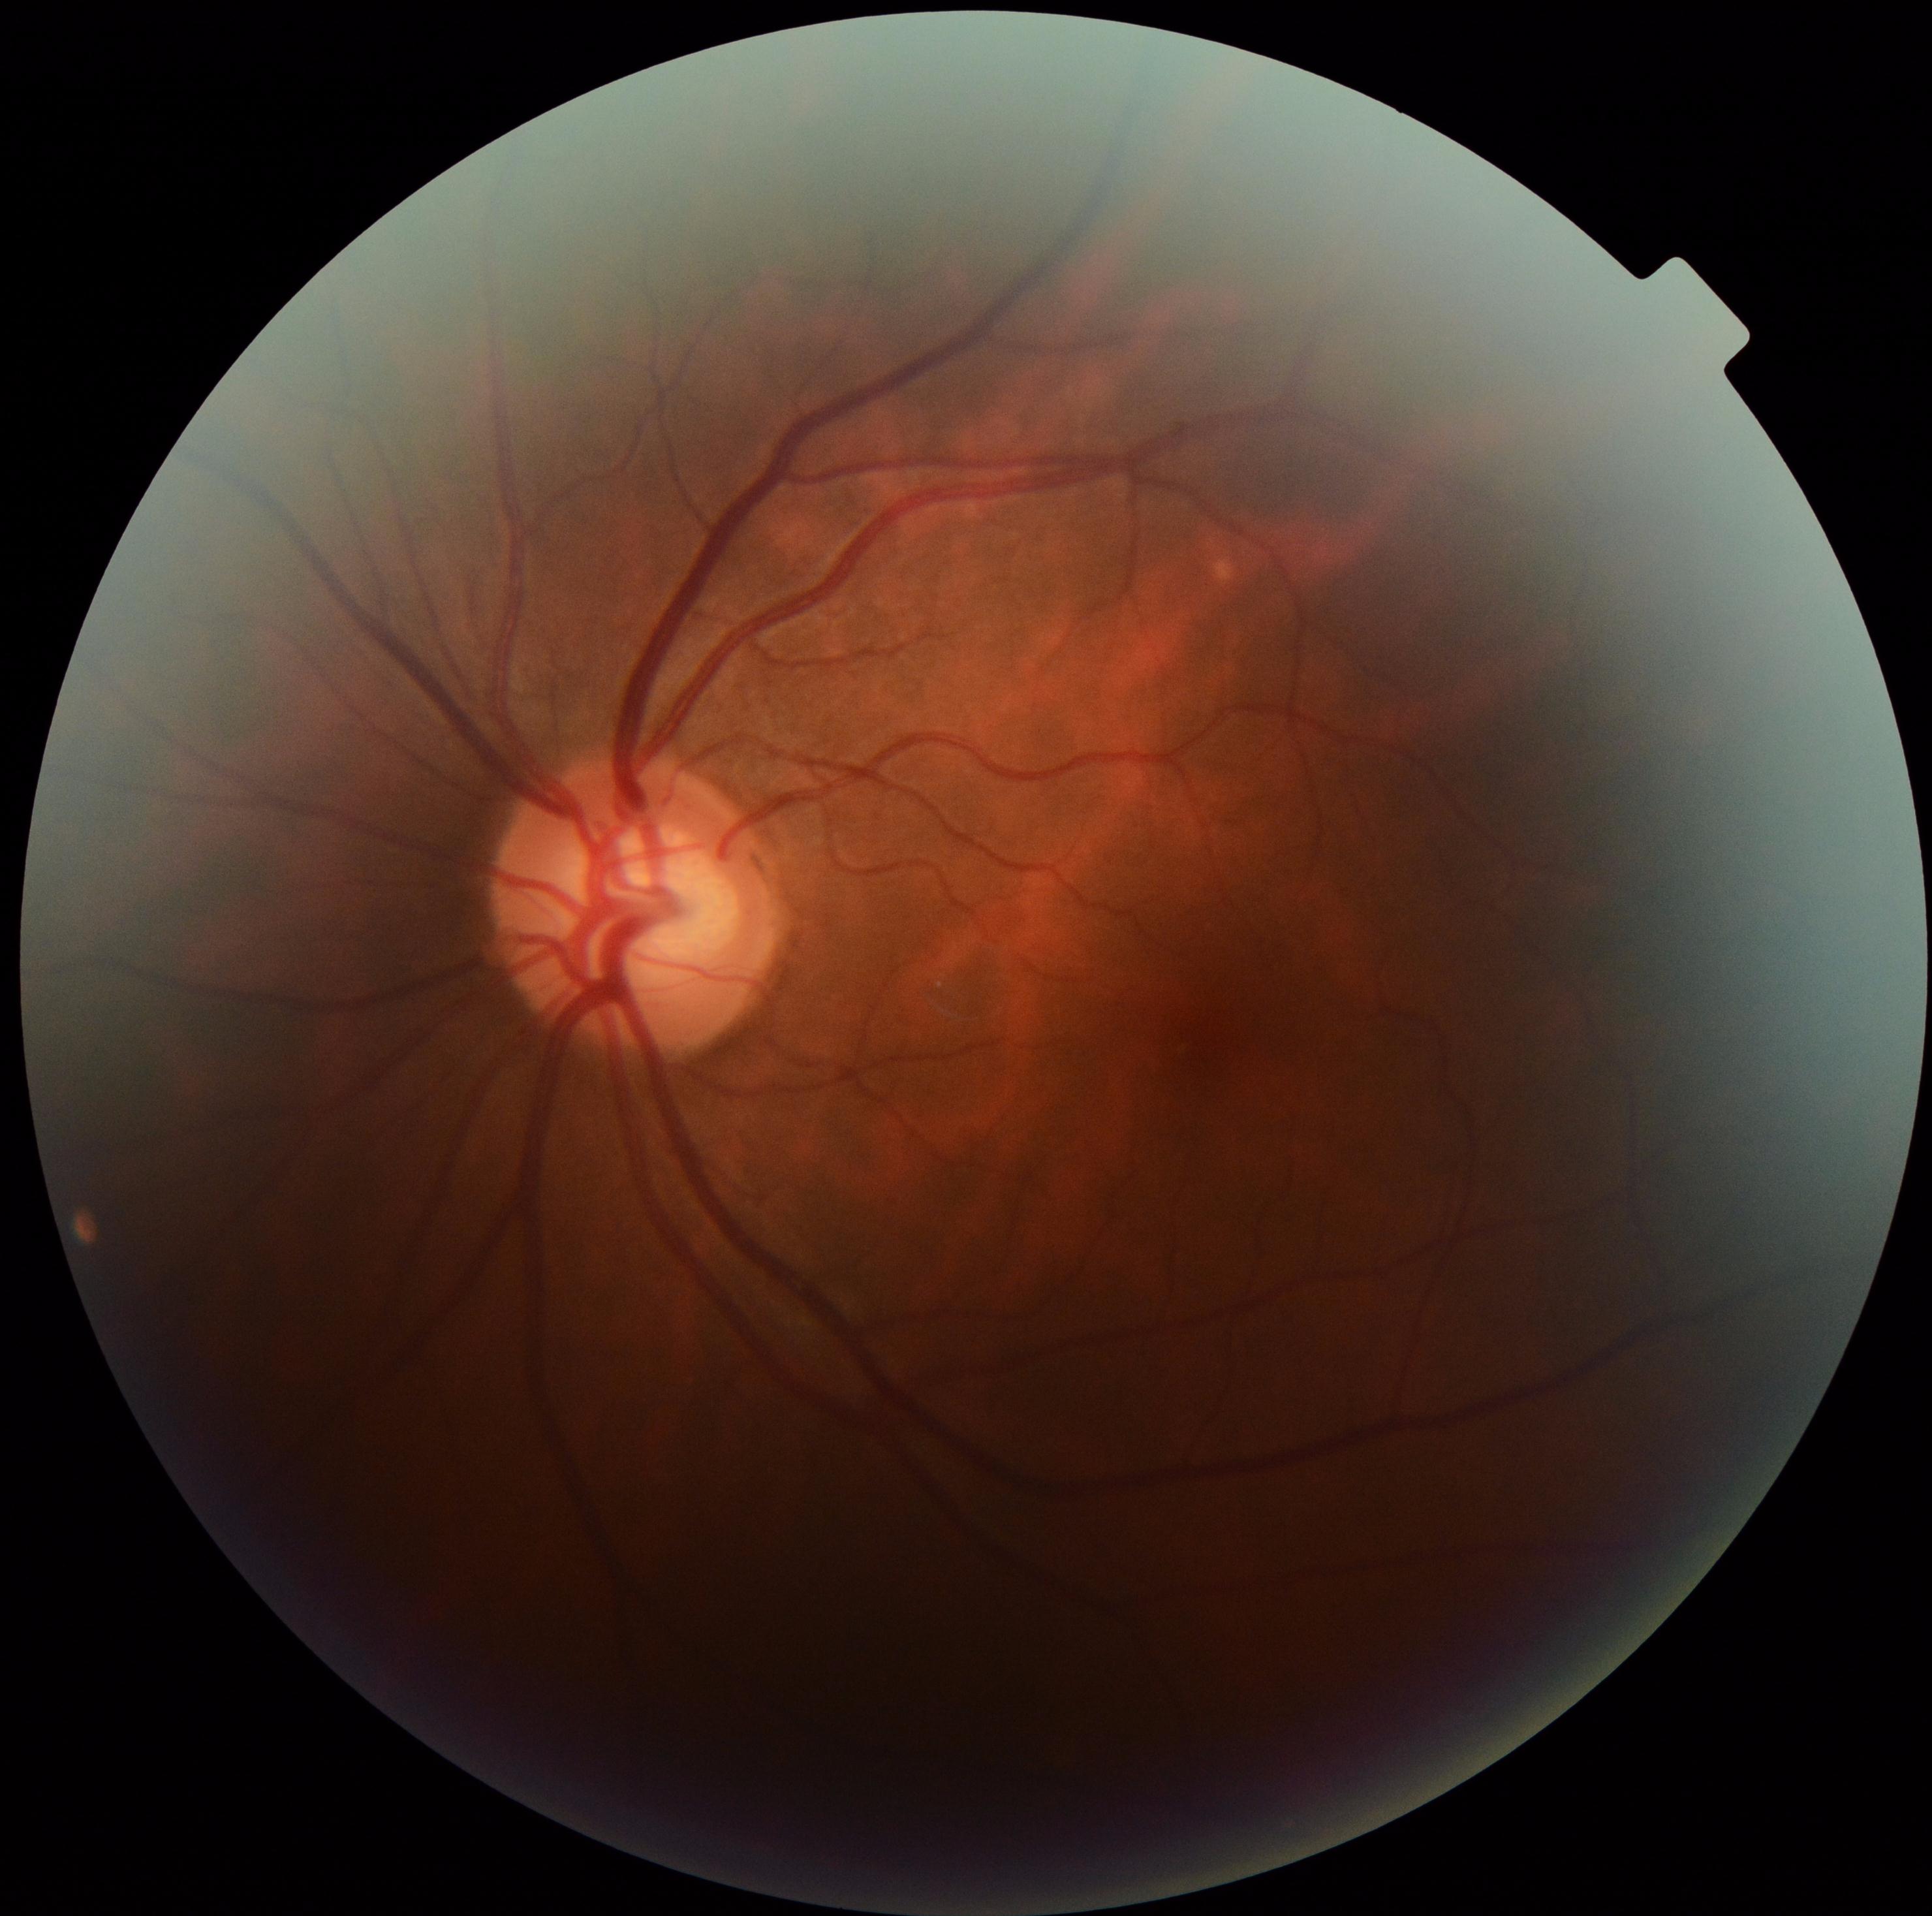 DR grade: 0 — no visible signs of diabetic retinopathy.